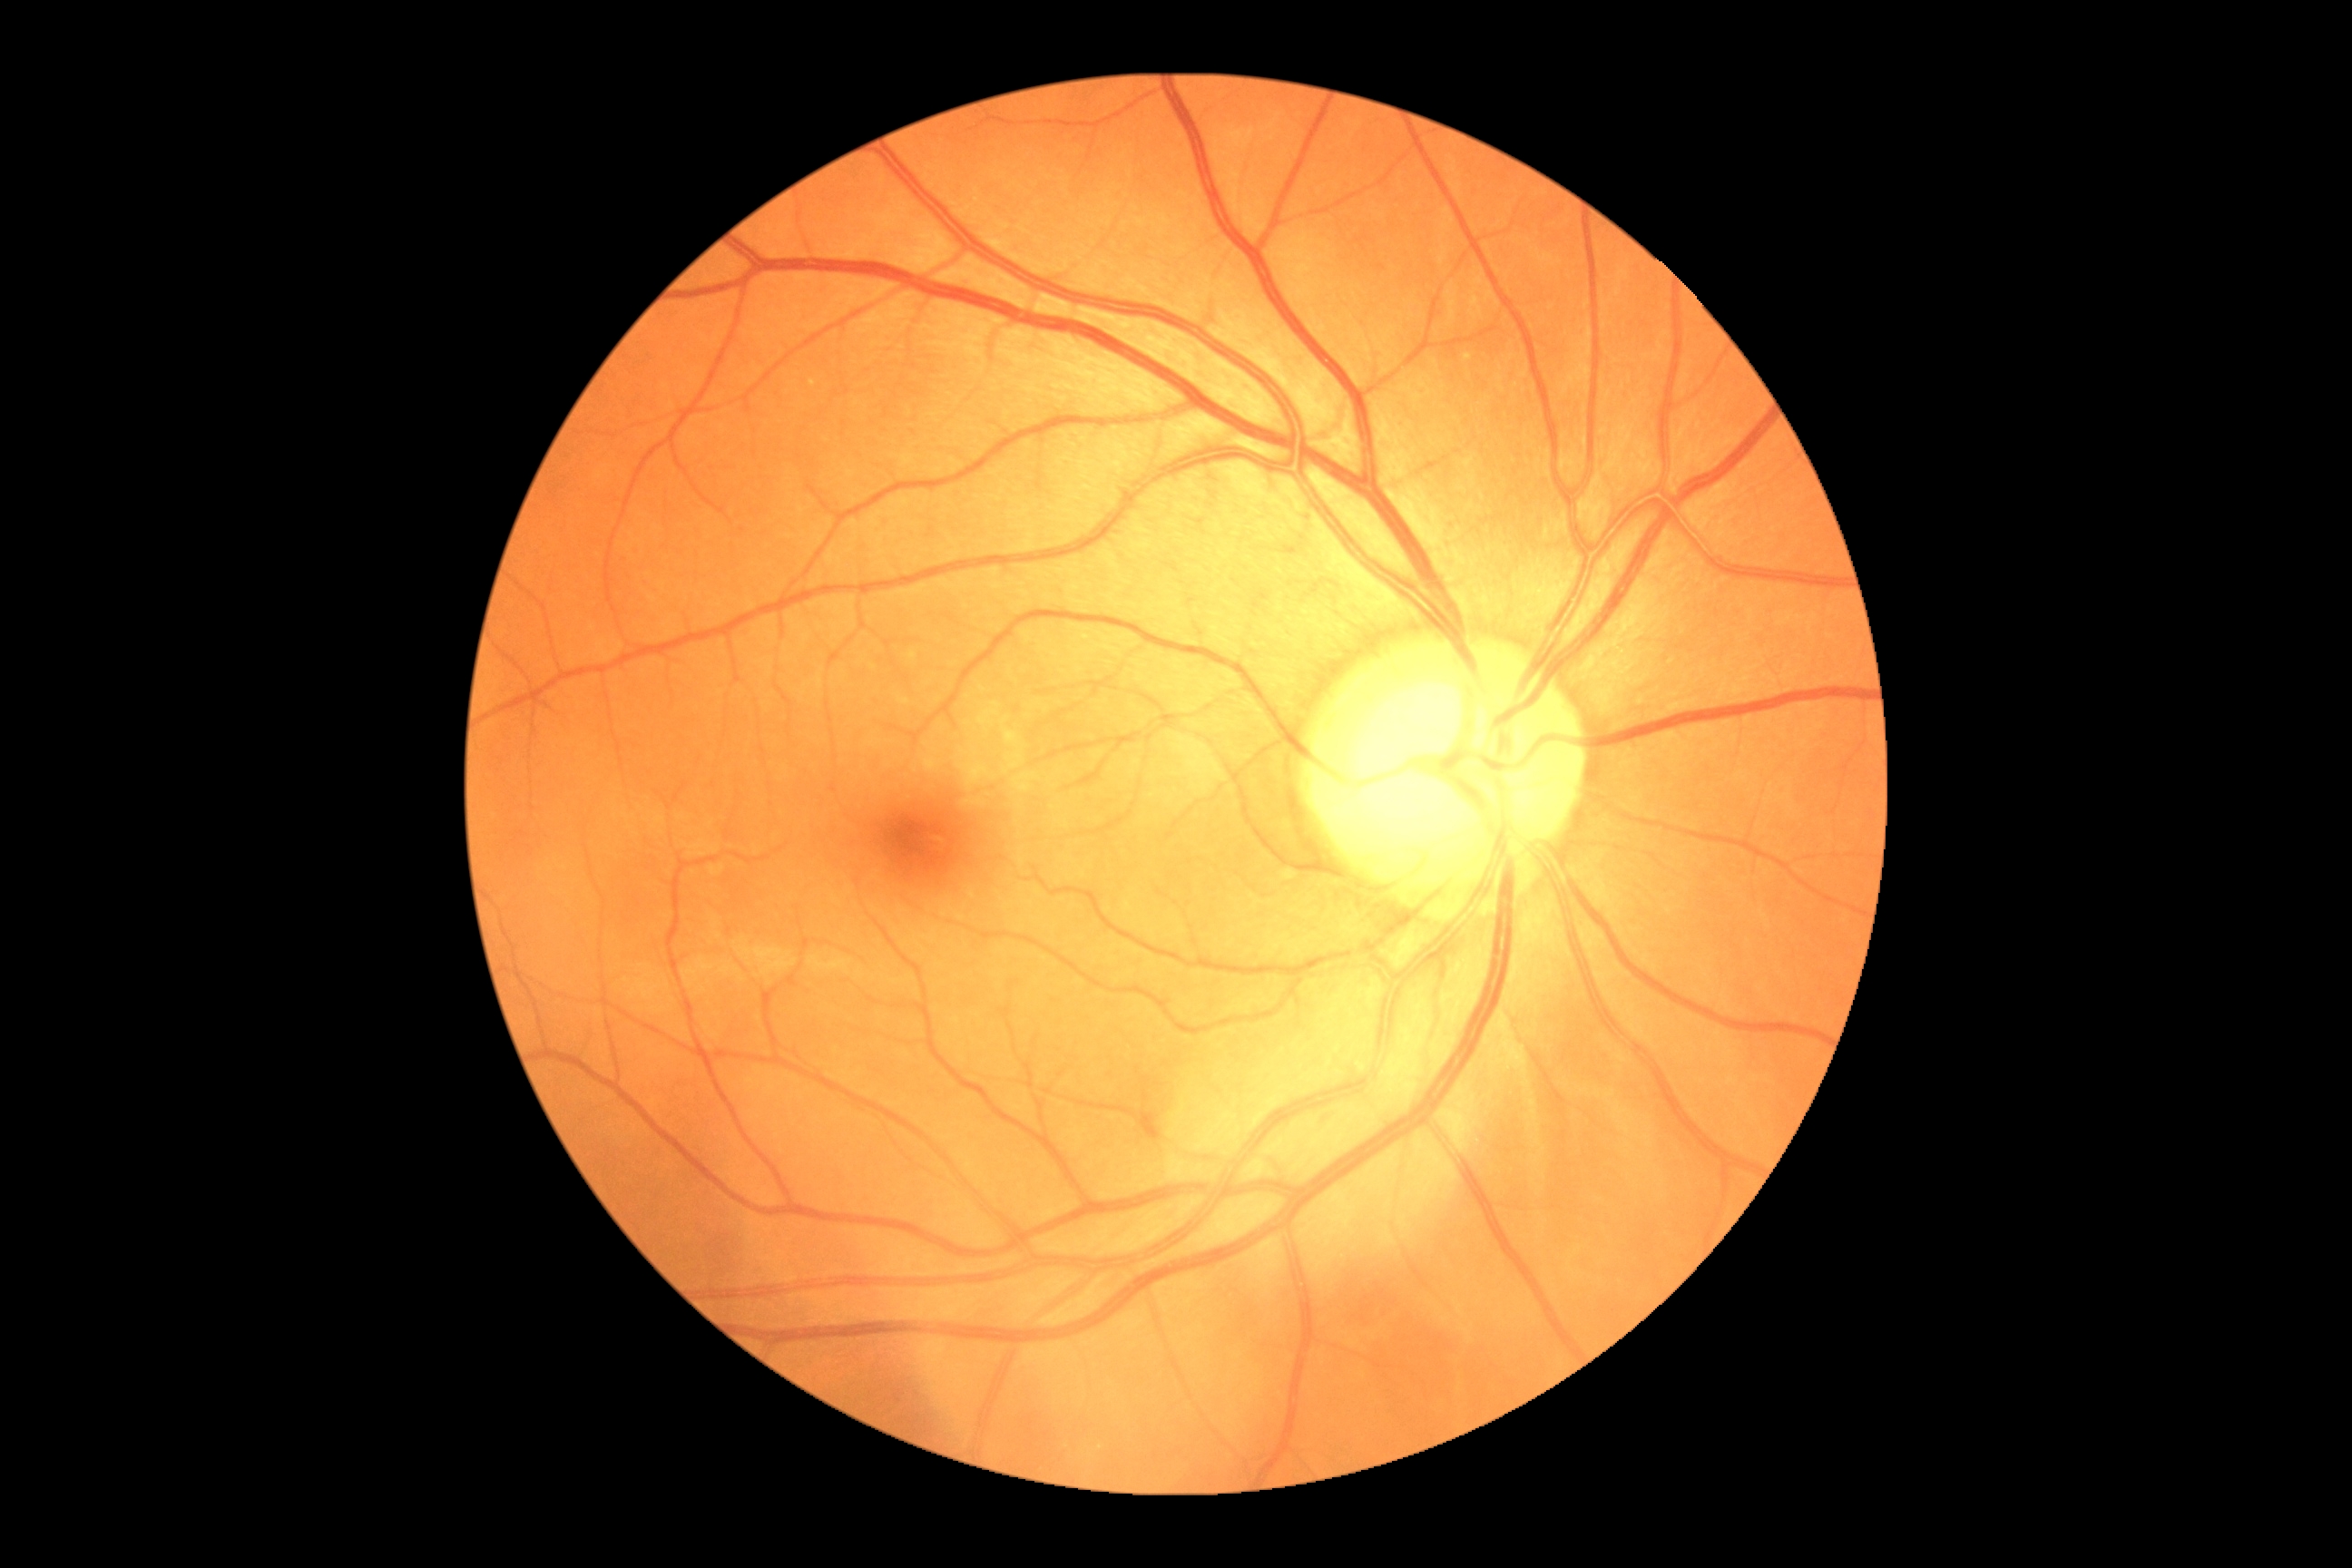 No DR findings.
Retinopathy grade is 0.